45-degree field of view · 2184 by 1690 pixels
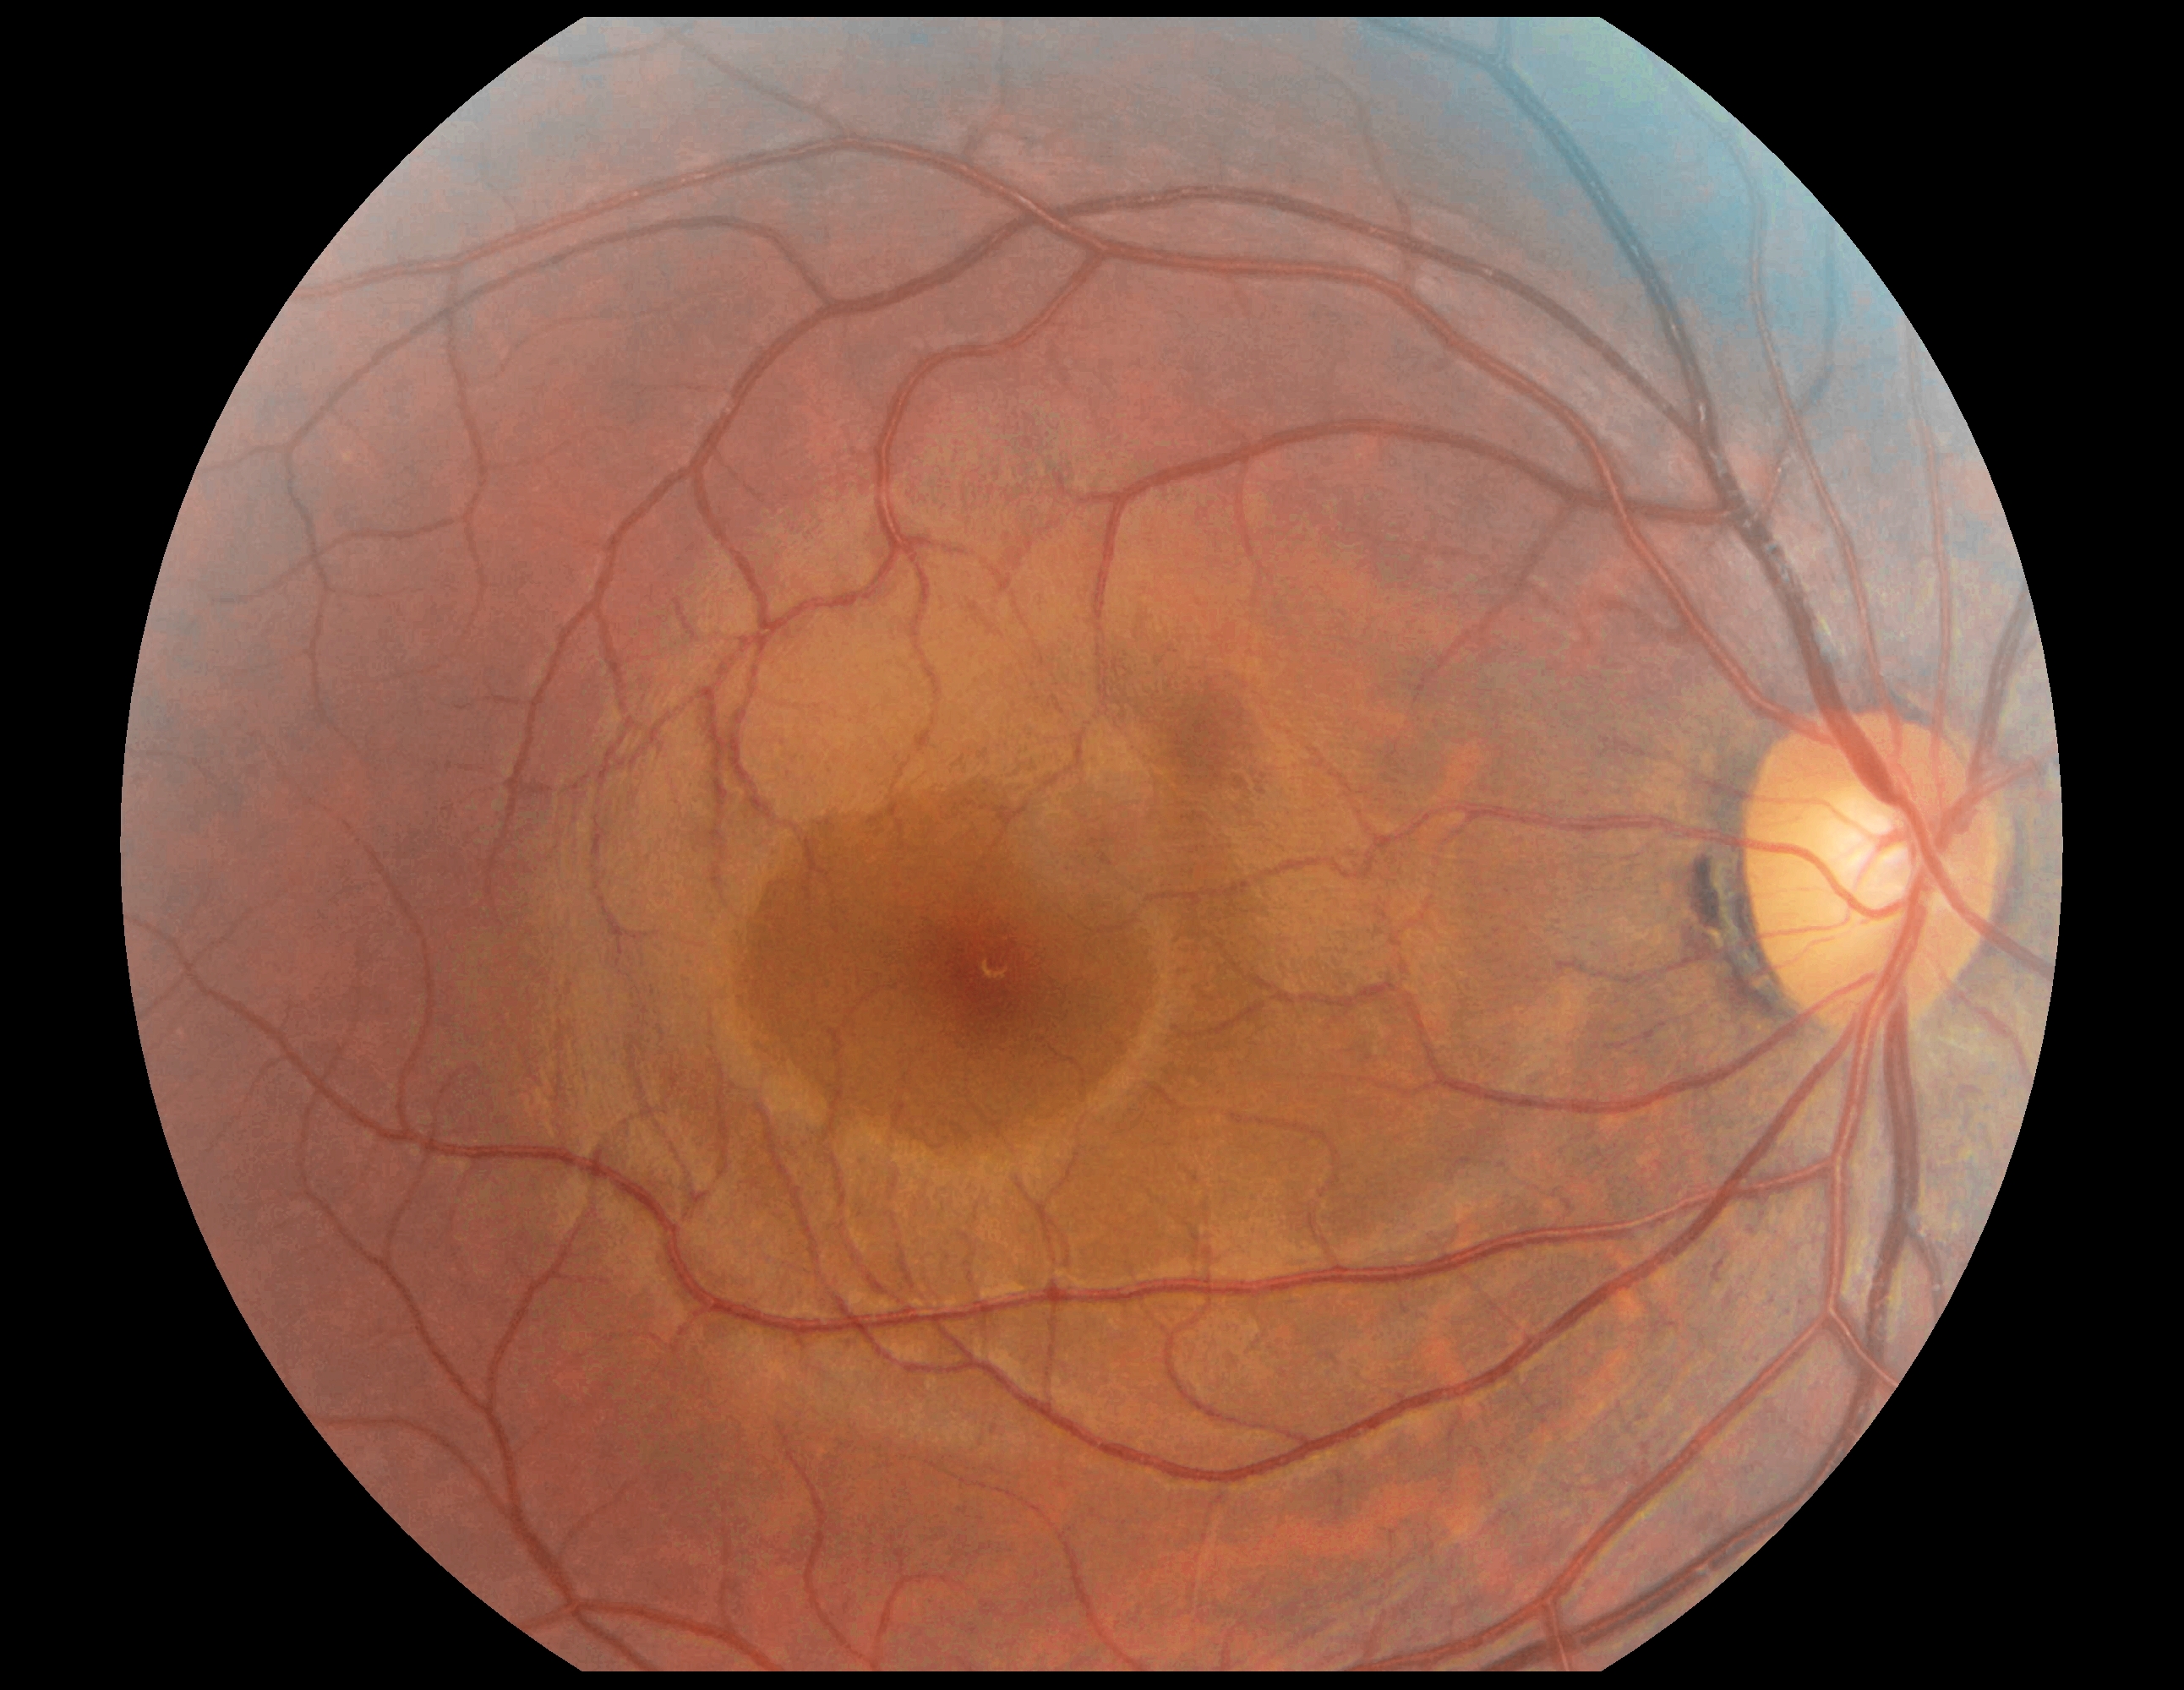
- DR: no apparent retinopathy (grade 0)